1380 by 1382 pixels · 45° field of view — 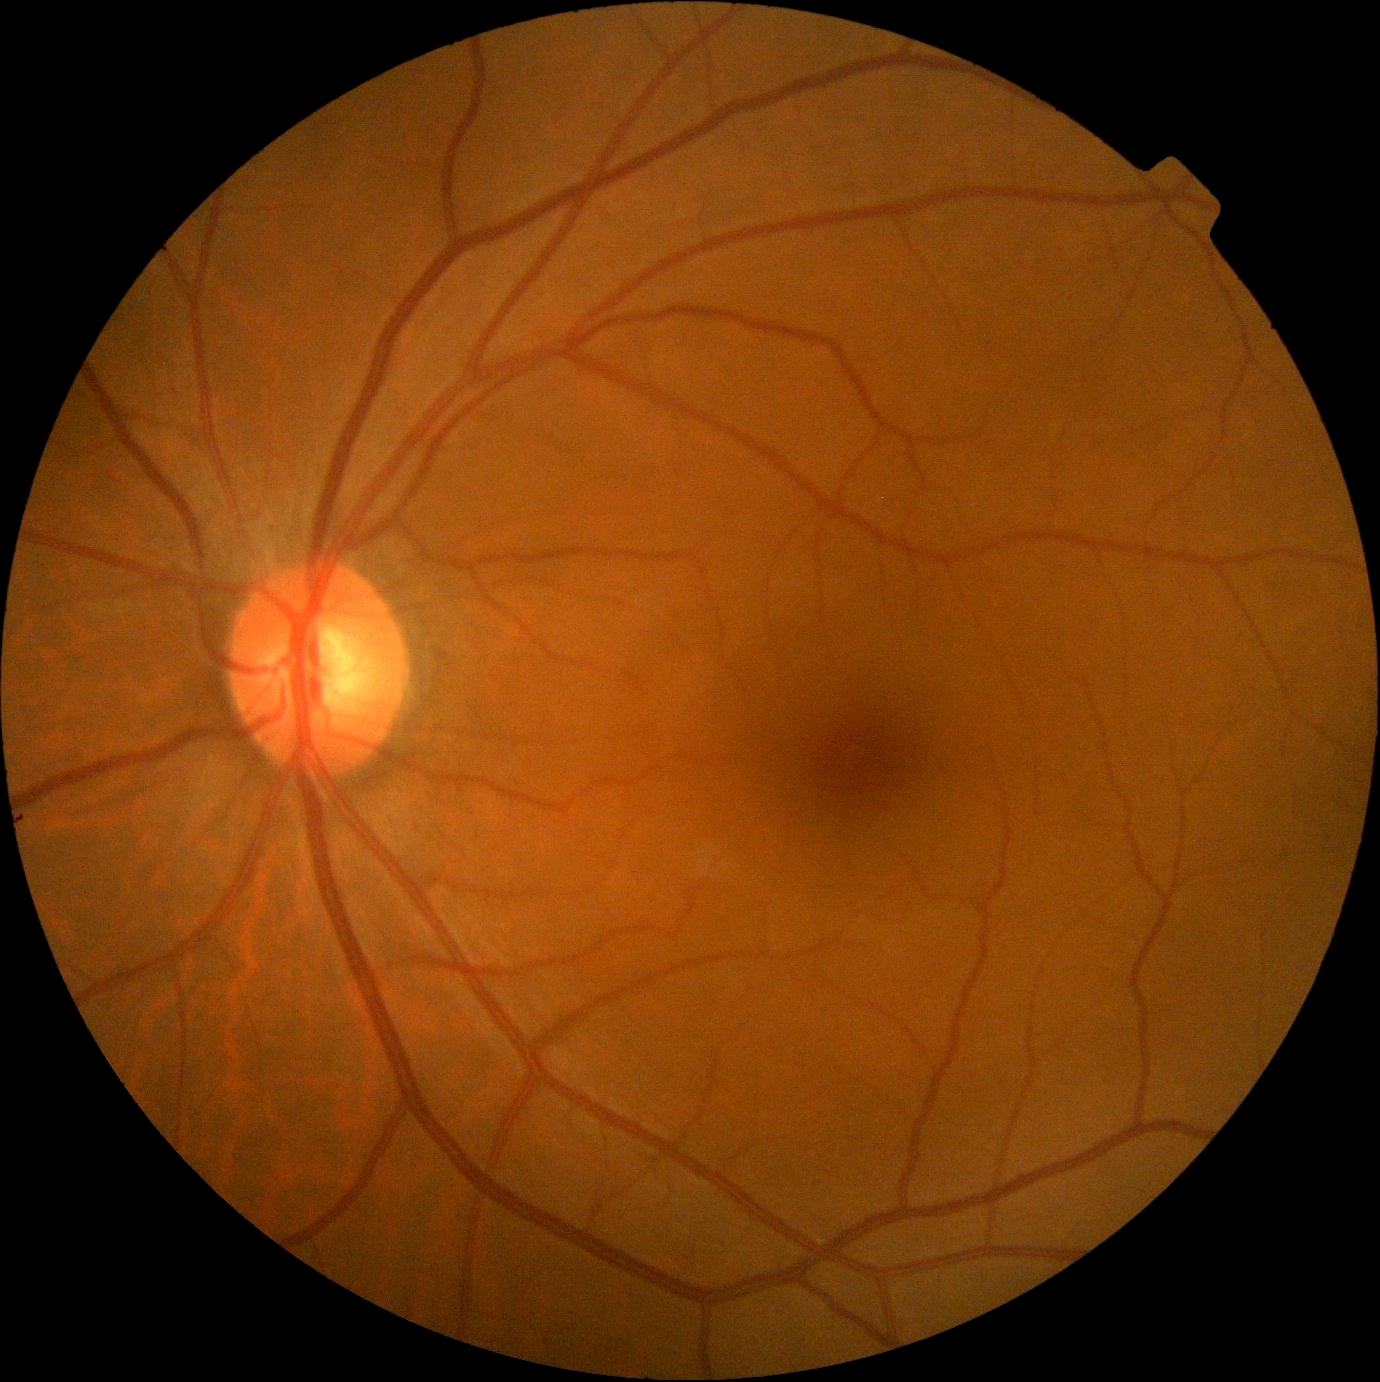
No signs of diabetic retinopathy.
DR grade: 0/4.